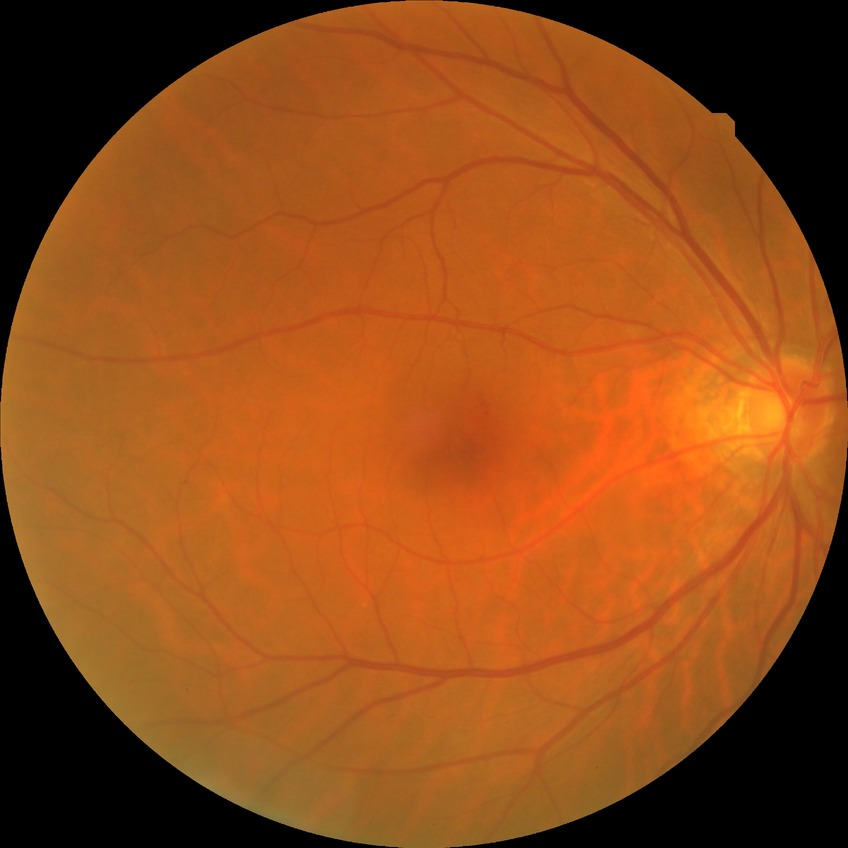

{
  "davis_grade": "simple diabetic retinopathy"
}